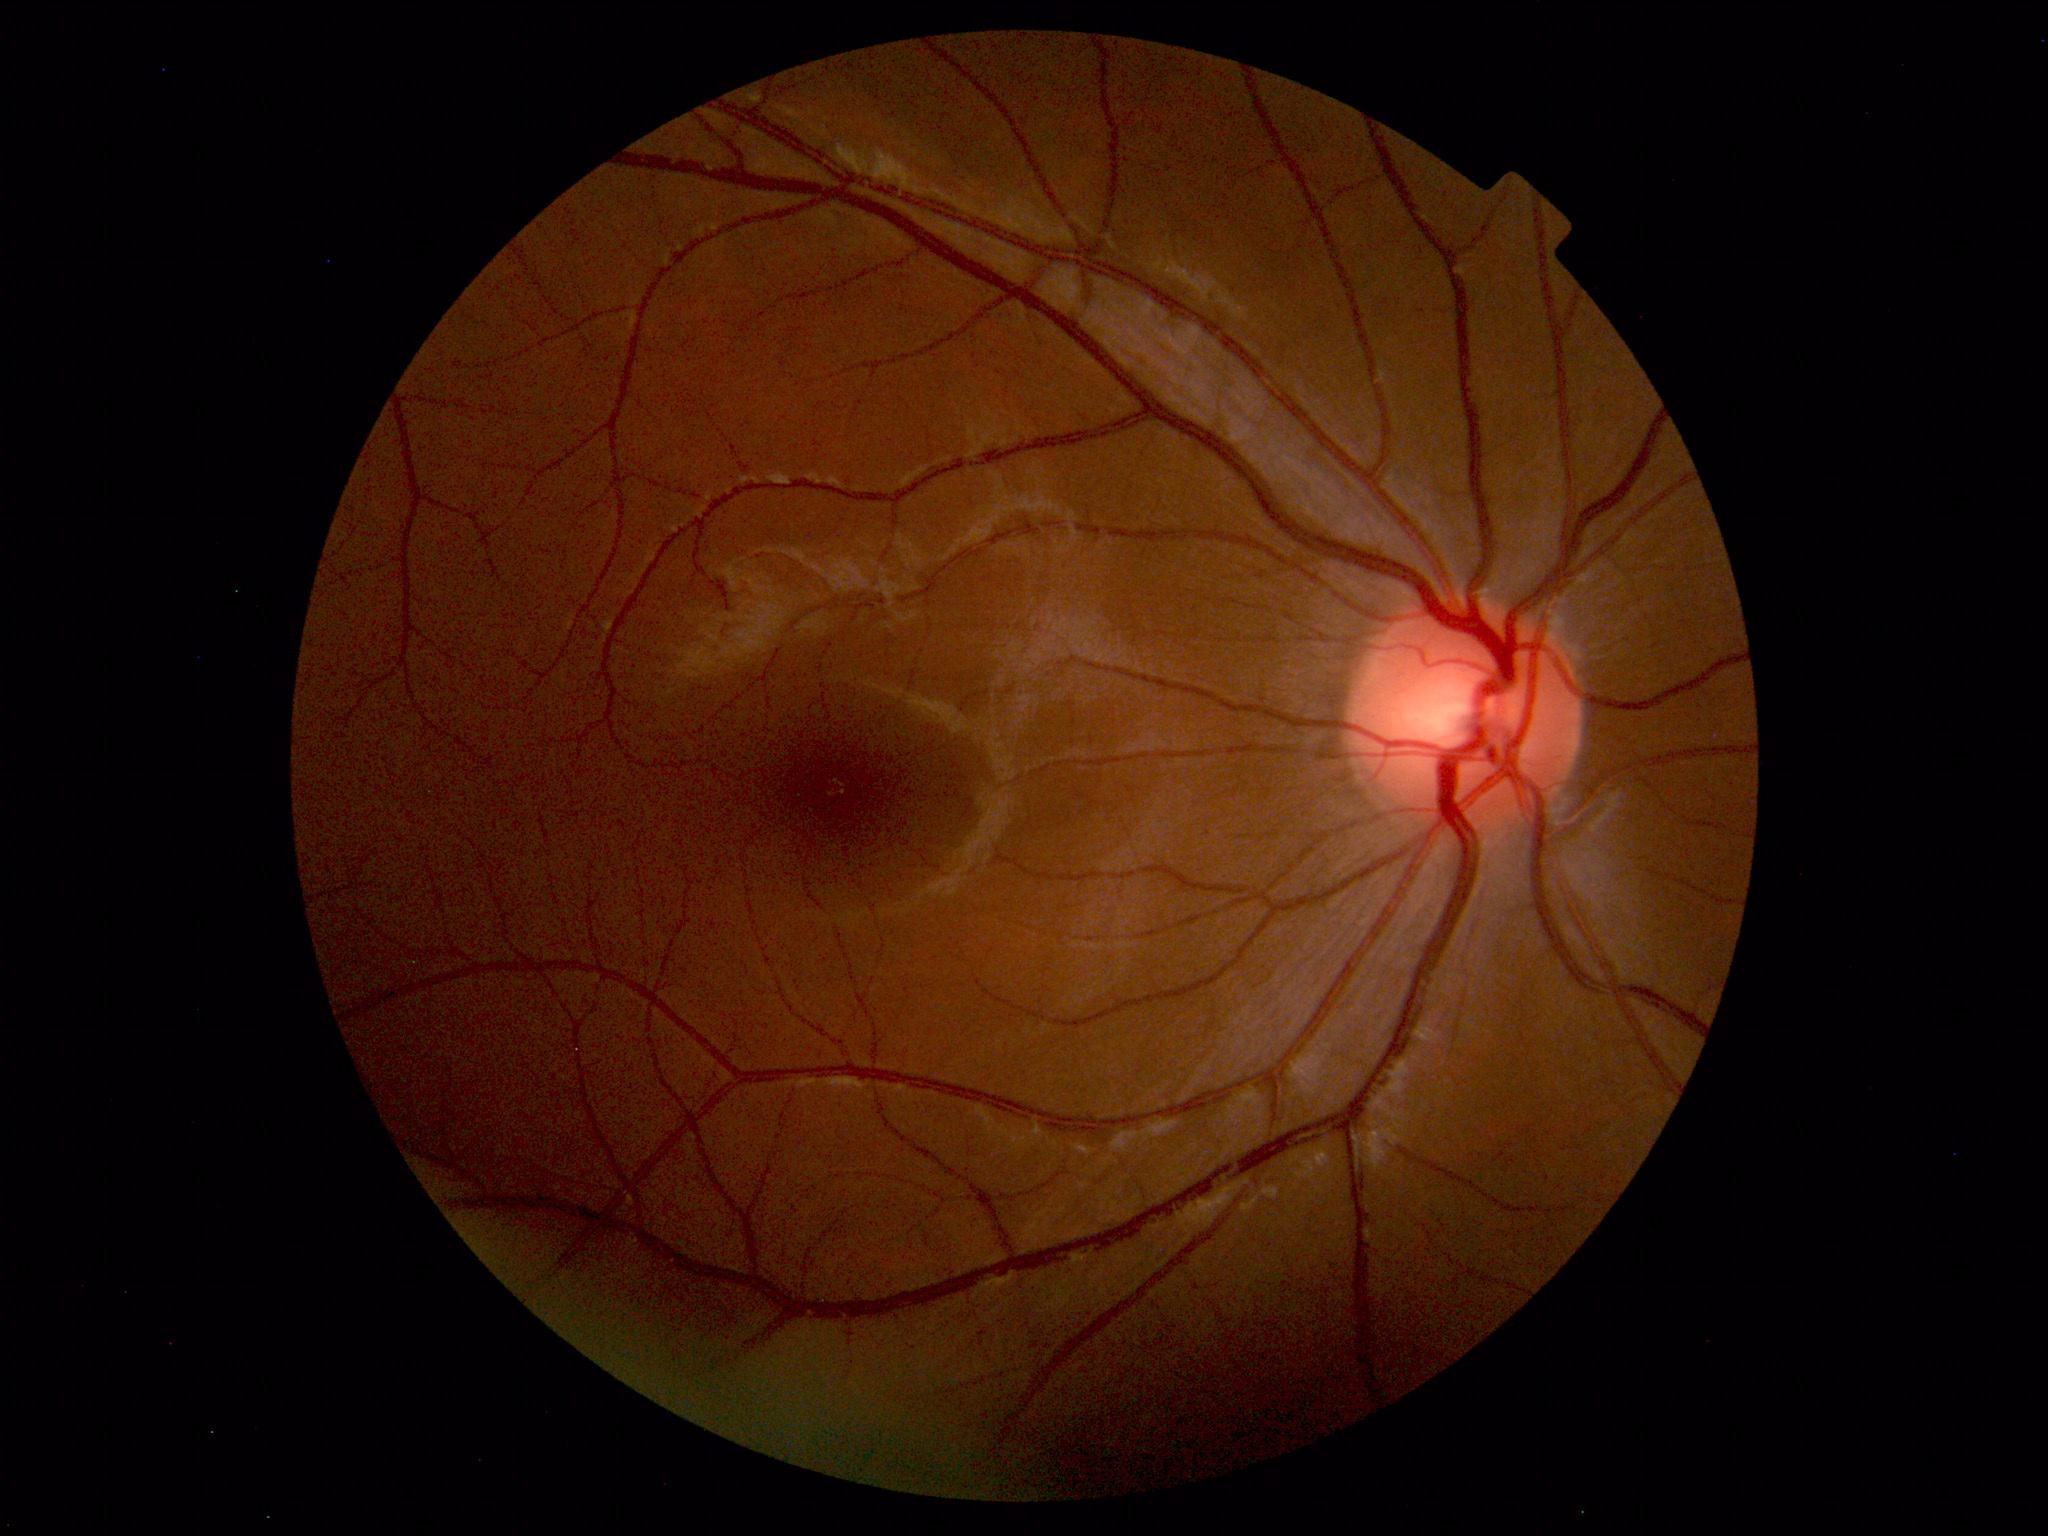 No abnormal findings on fundus examination.